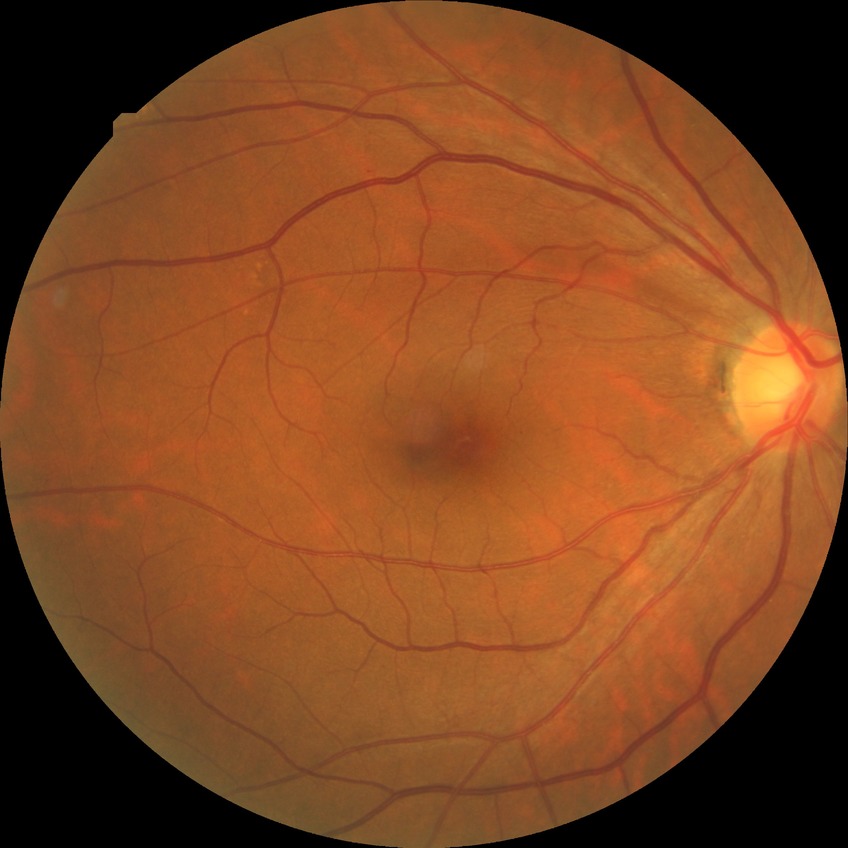 diabetic retinopathy (DR): NDR (no diabetic retinopathy)